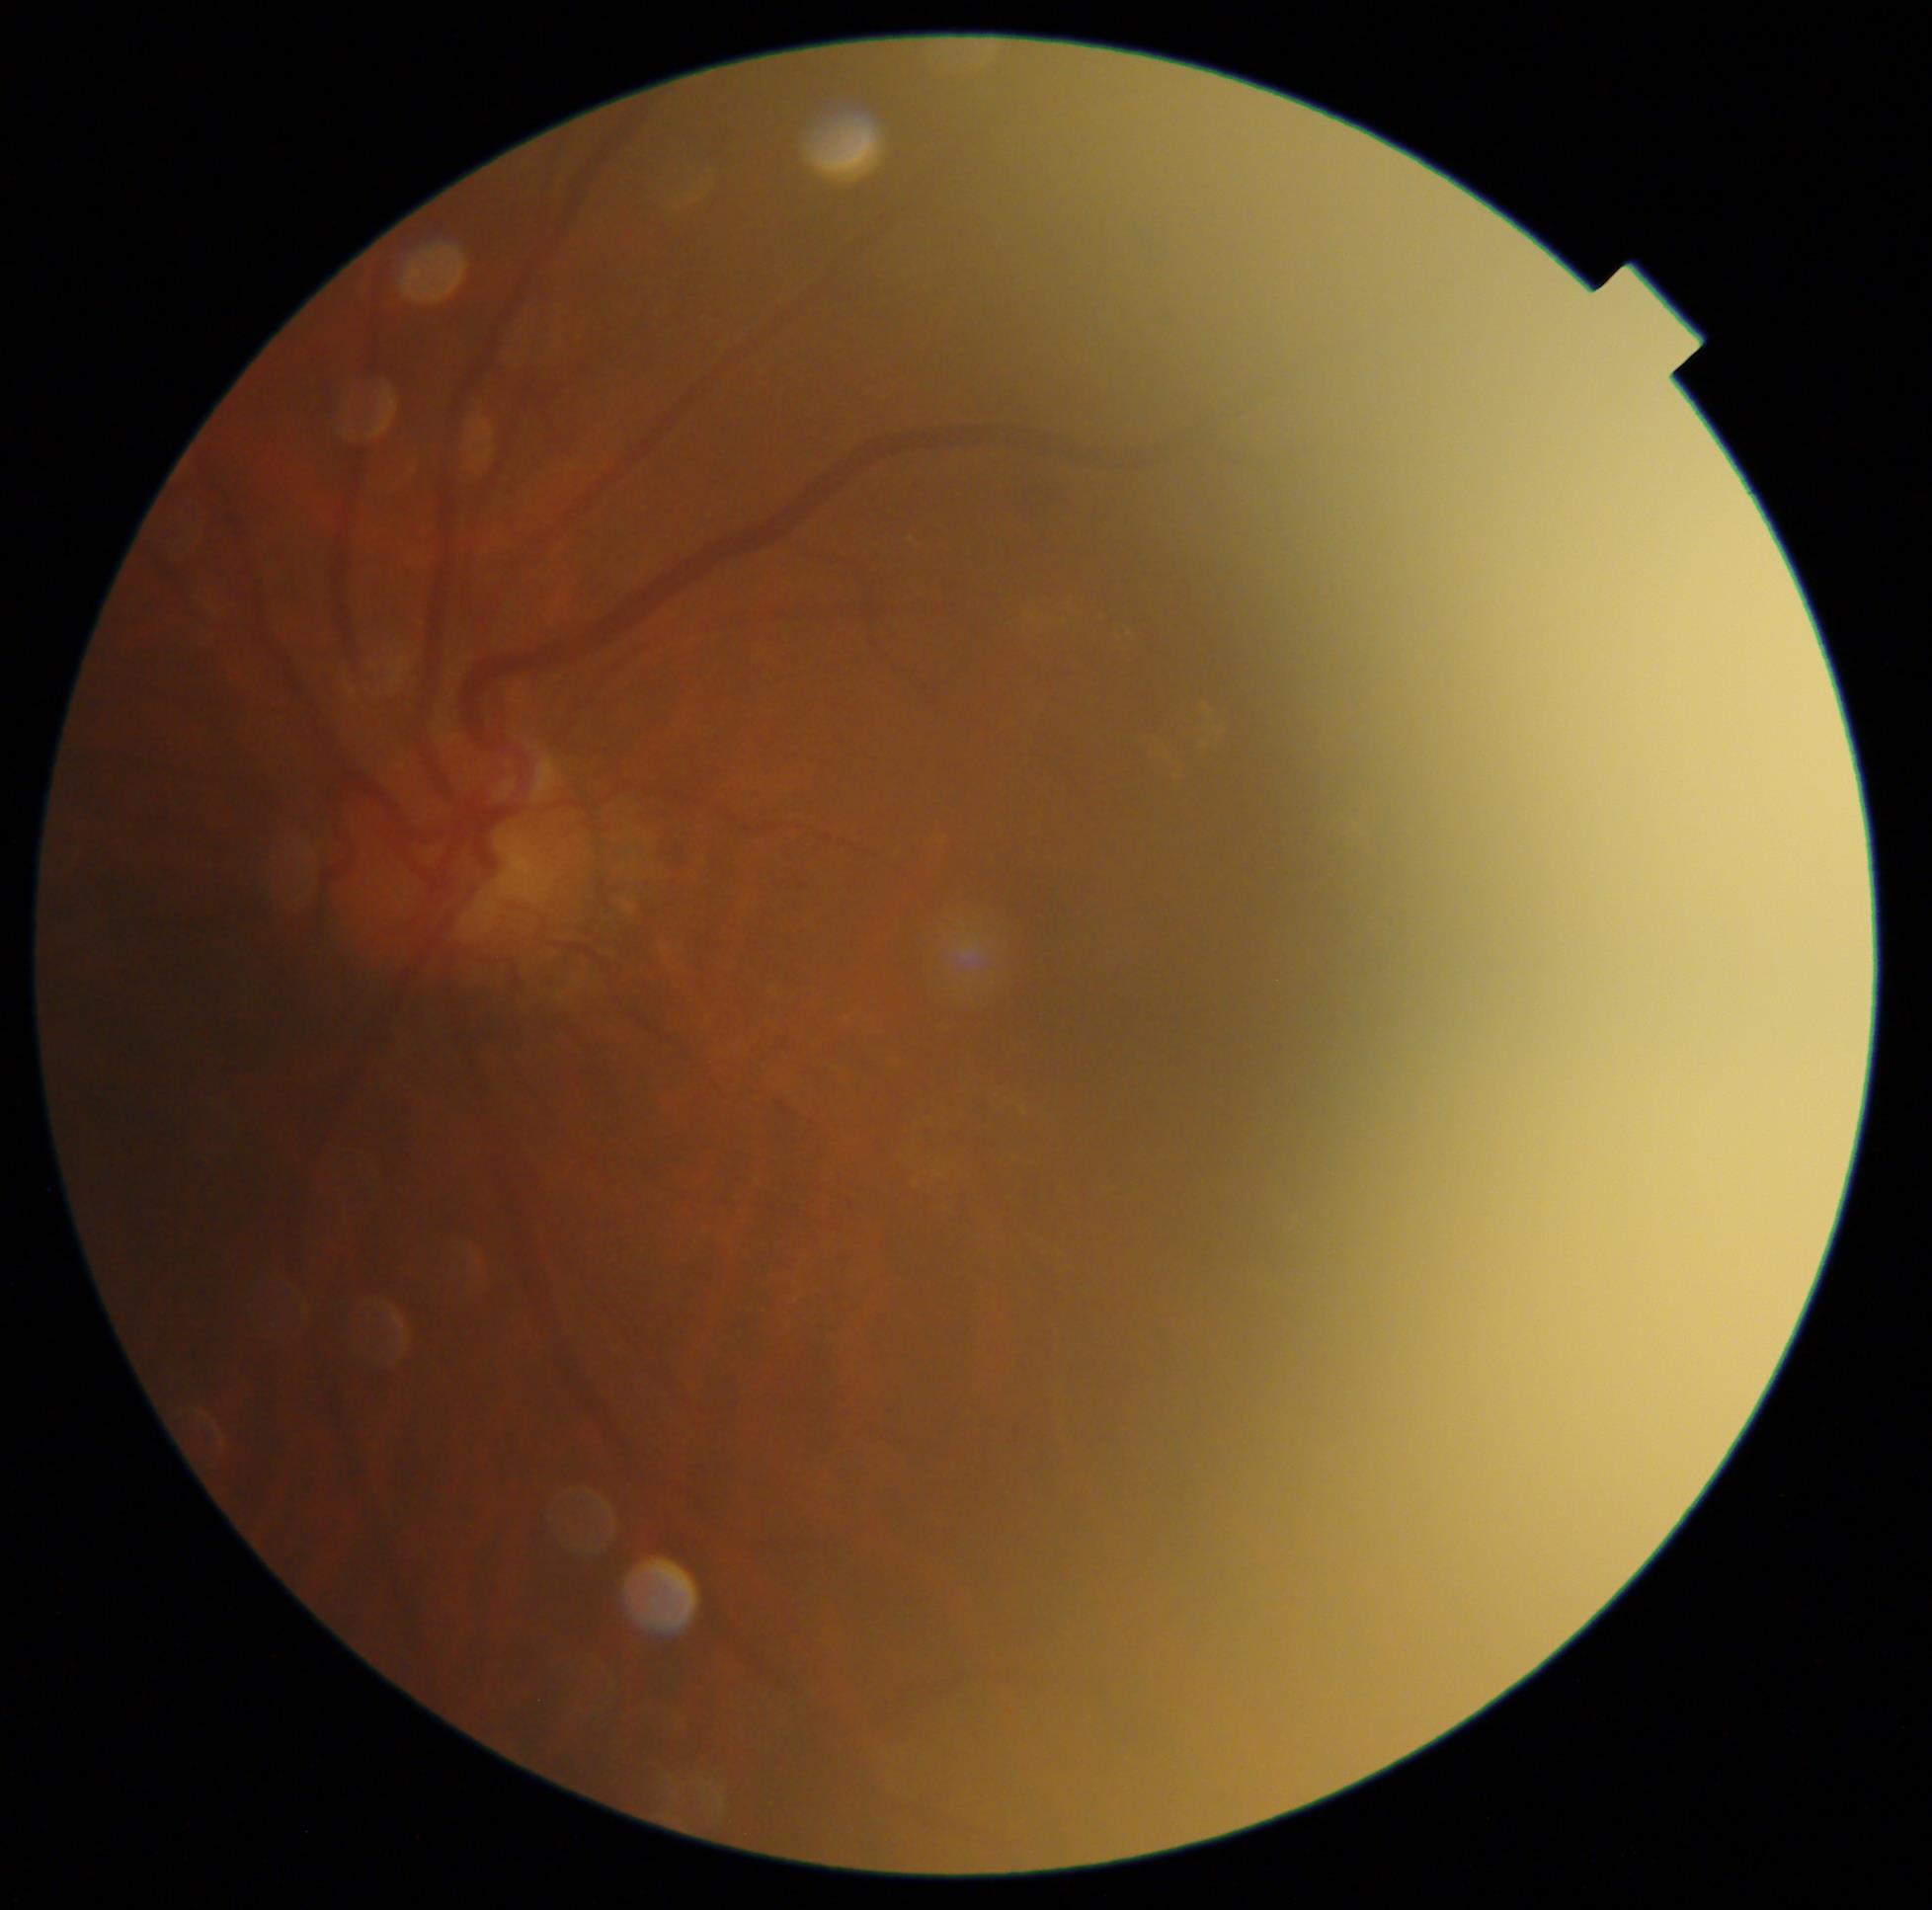
  dr_grade: 2/4 — more than just microaneurysms but less than severe NPDR